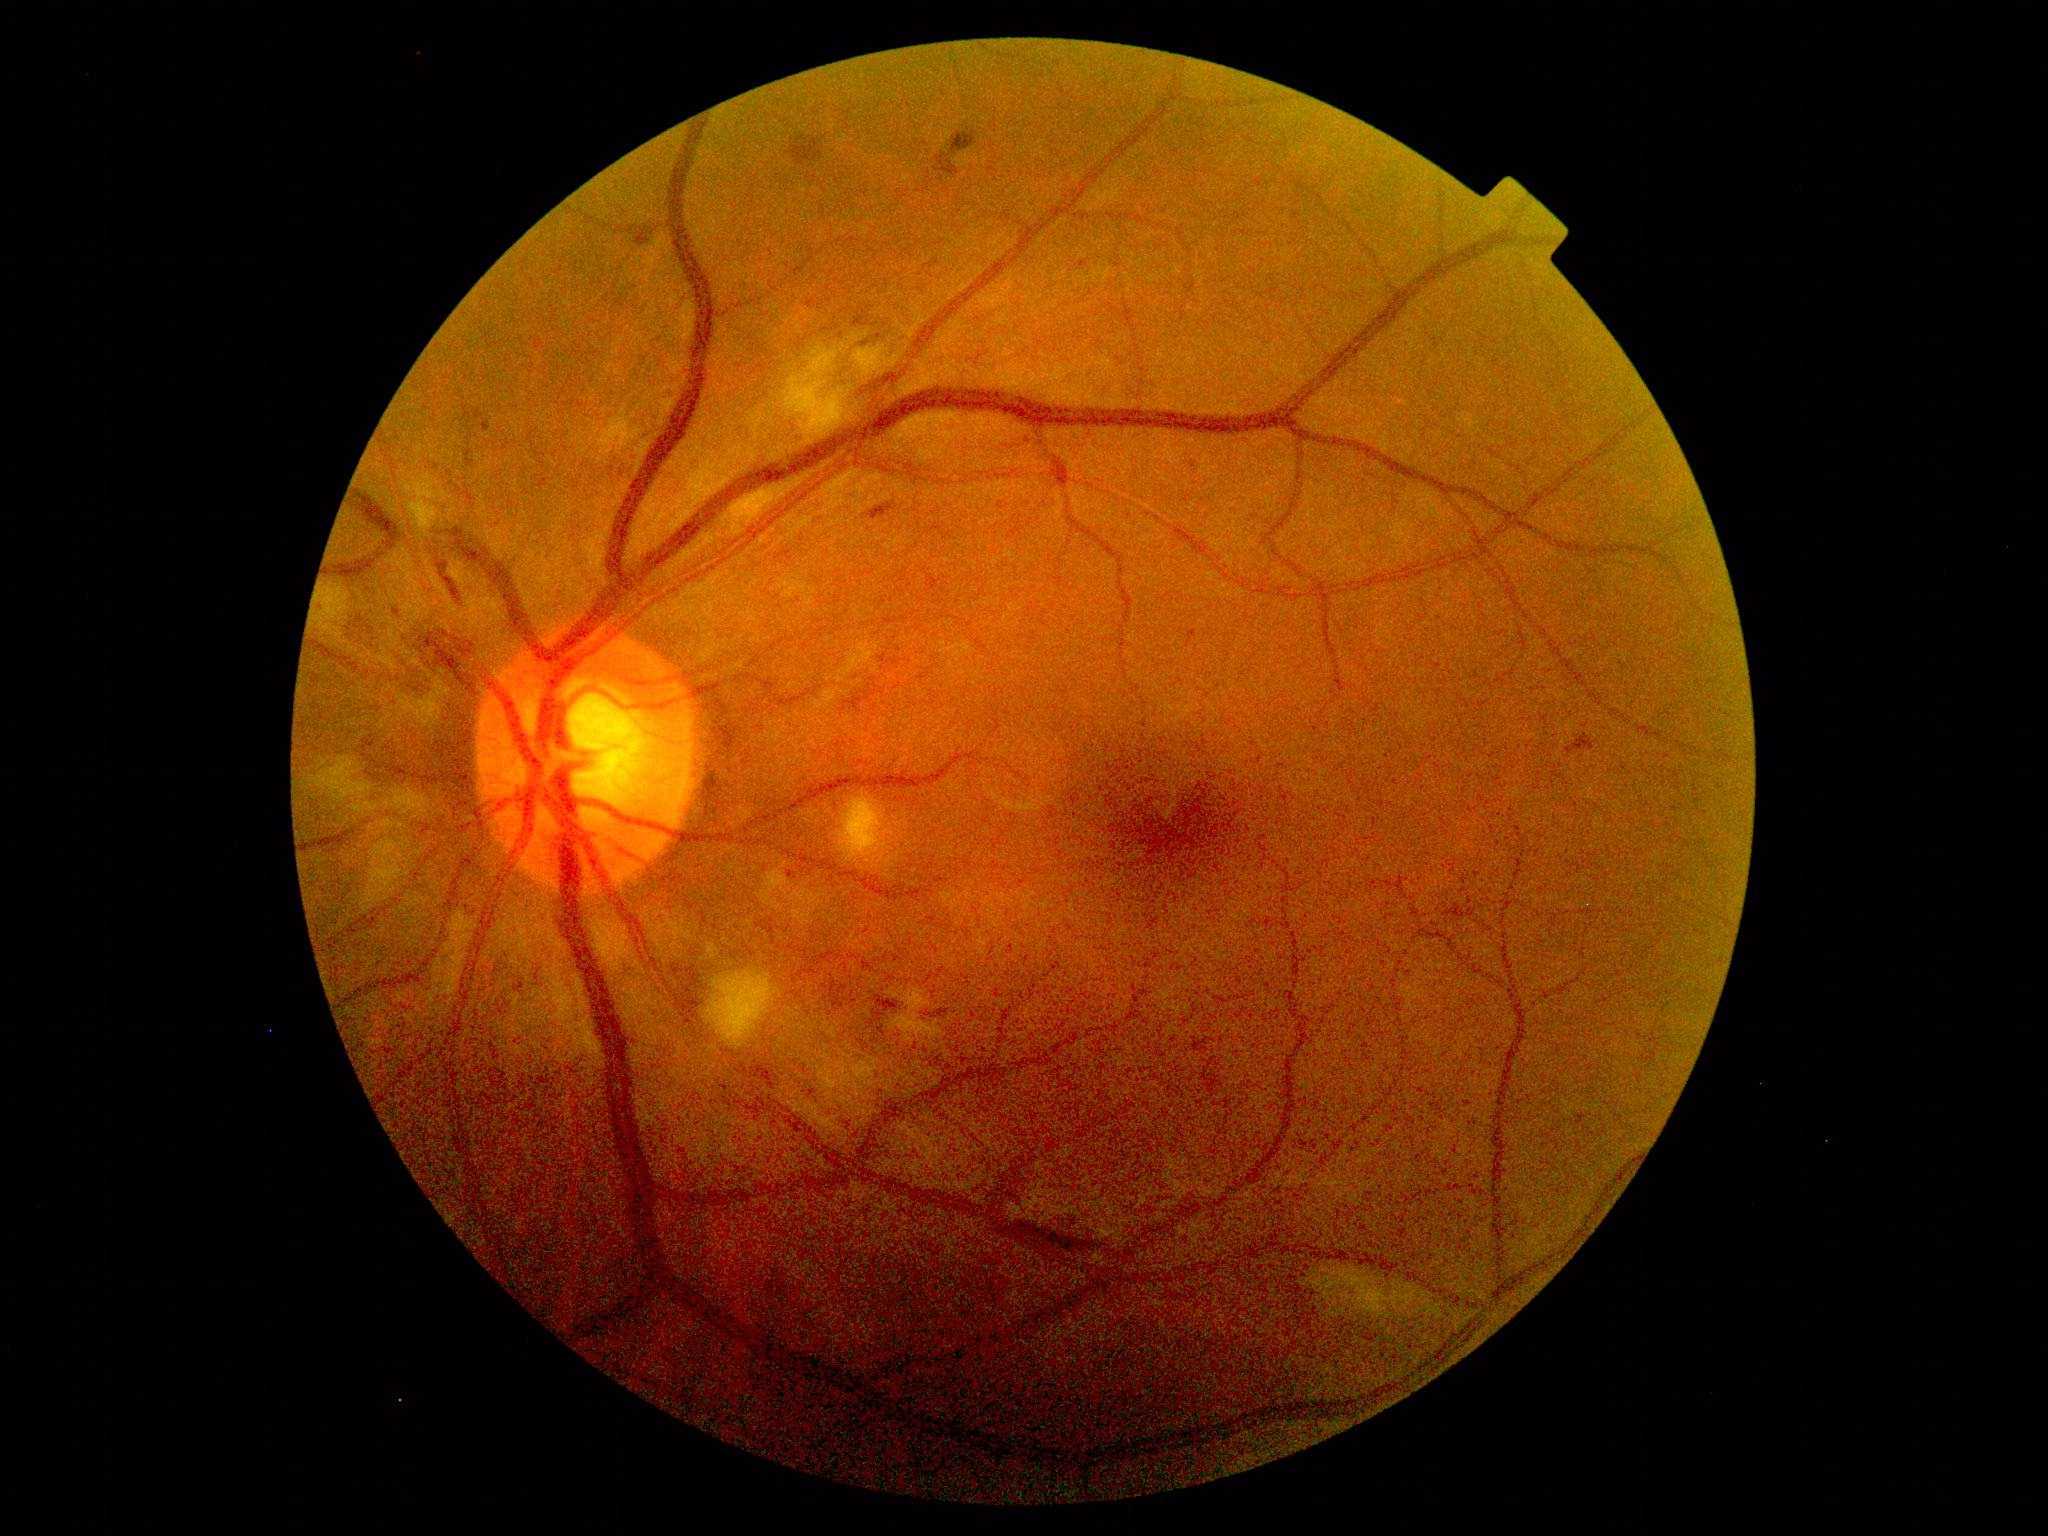 Diabetic retinopathy severity: grade 2 (moderate NPDR).